1920x1440. Captured on a Bosch handheld camera. Color fundus photograph: 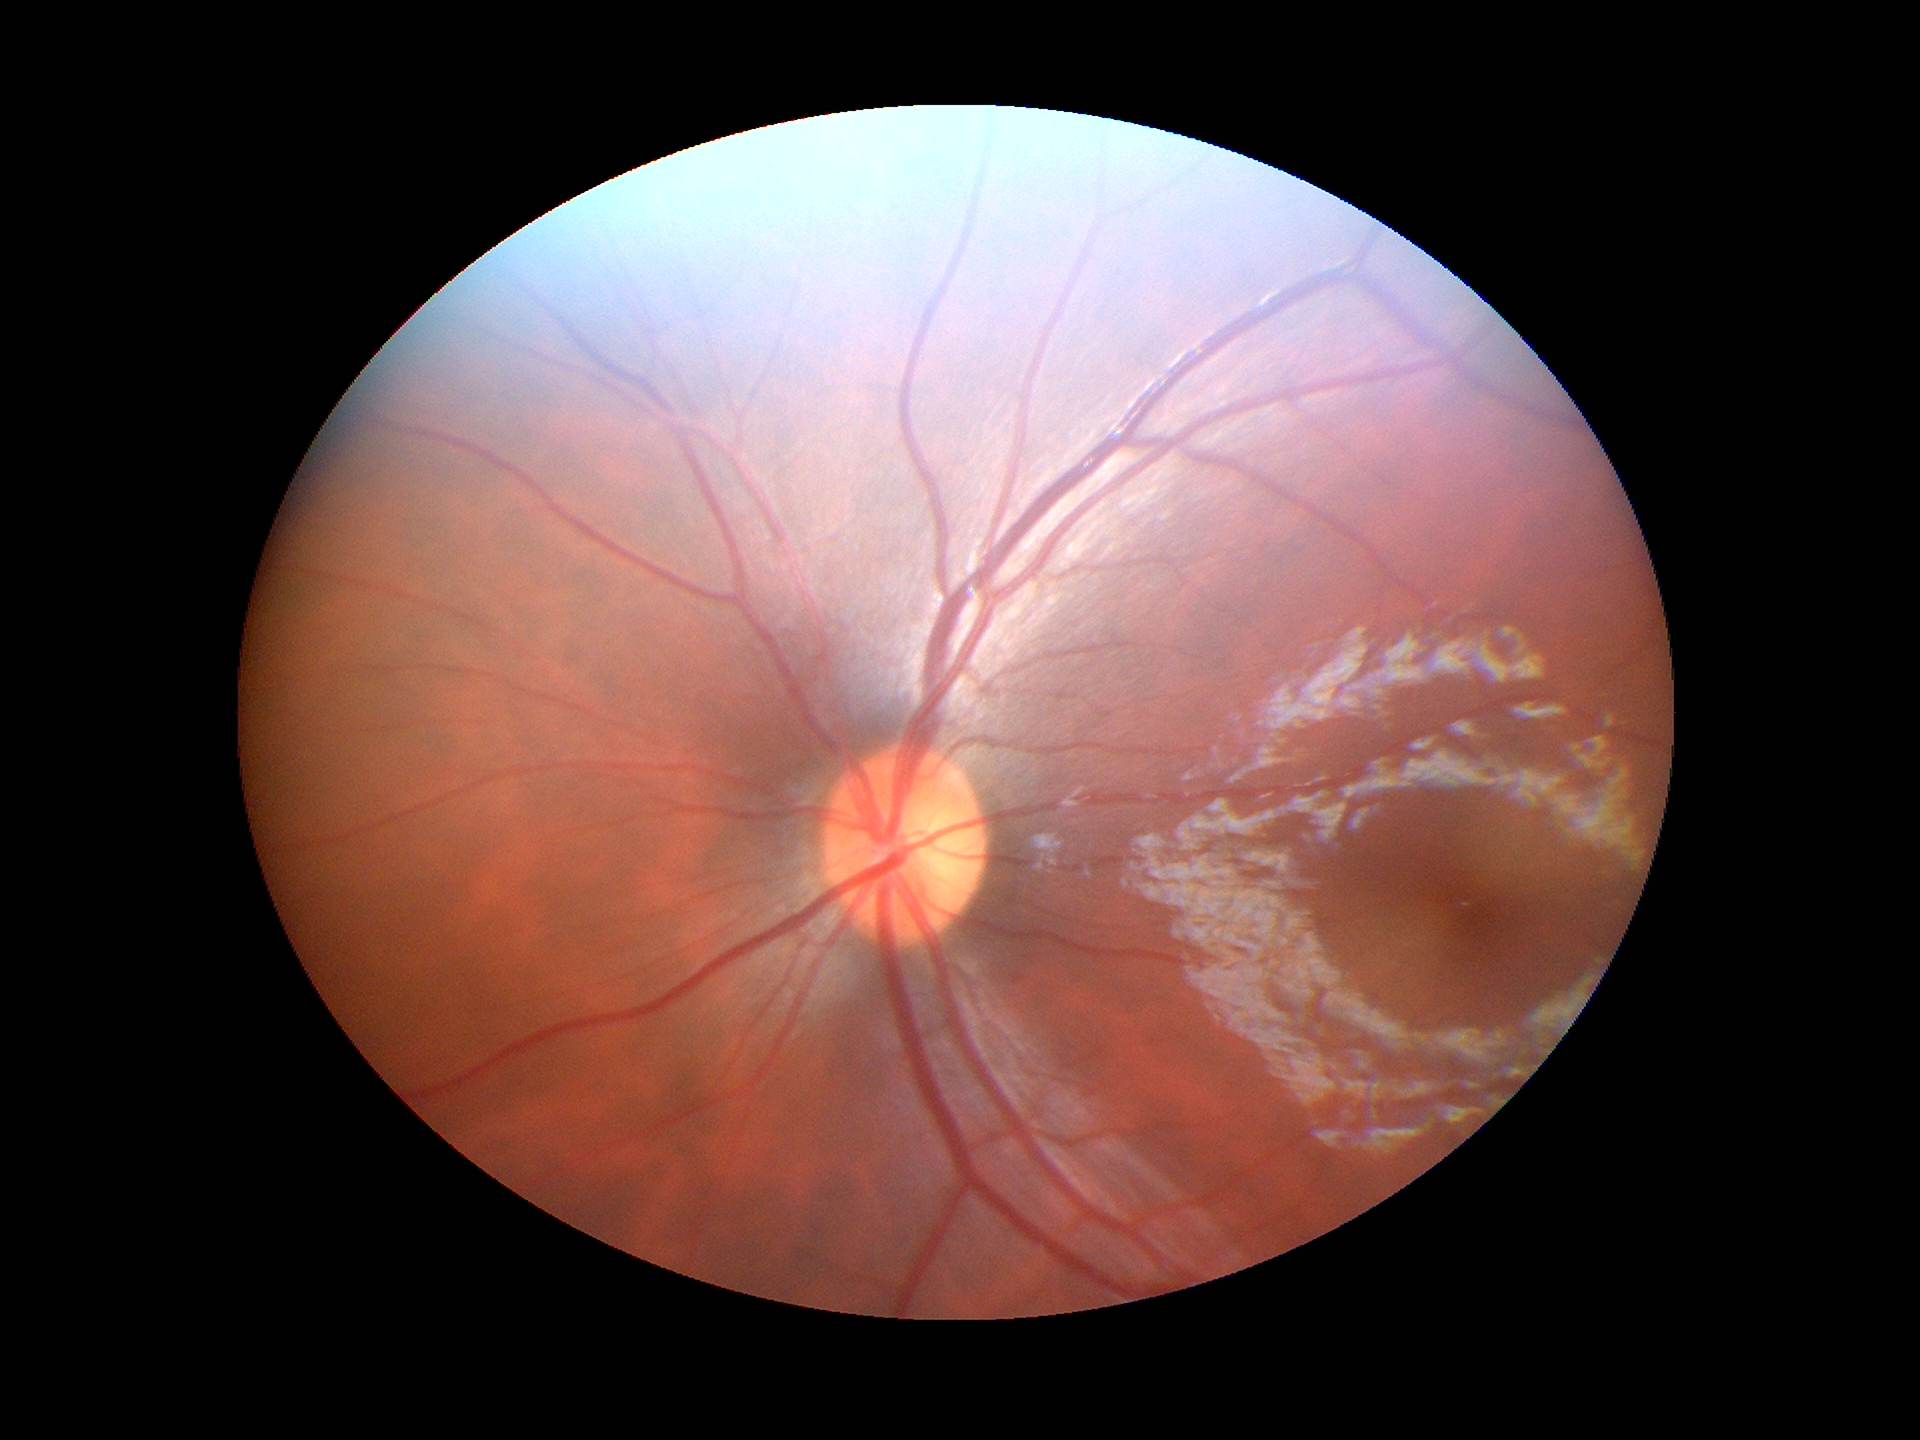
Vertical cup-disc ratio (VCDR) is 0.48.
Horizontal cup-to-disc ratio (HCDR): 0.49.
Not suspicious for glaucoma.